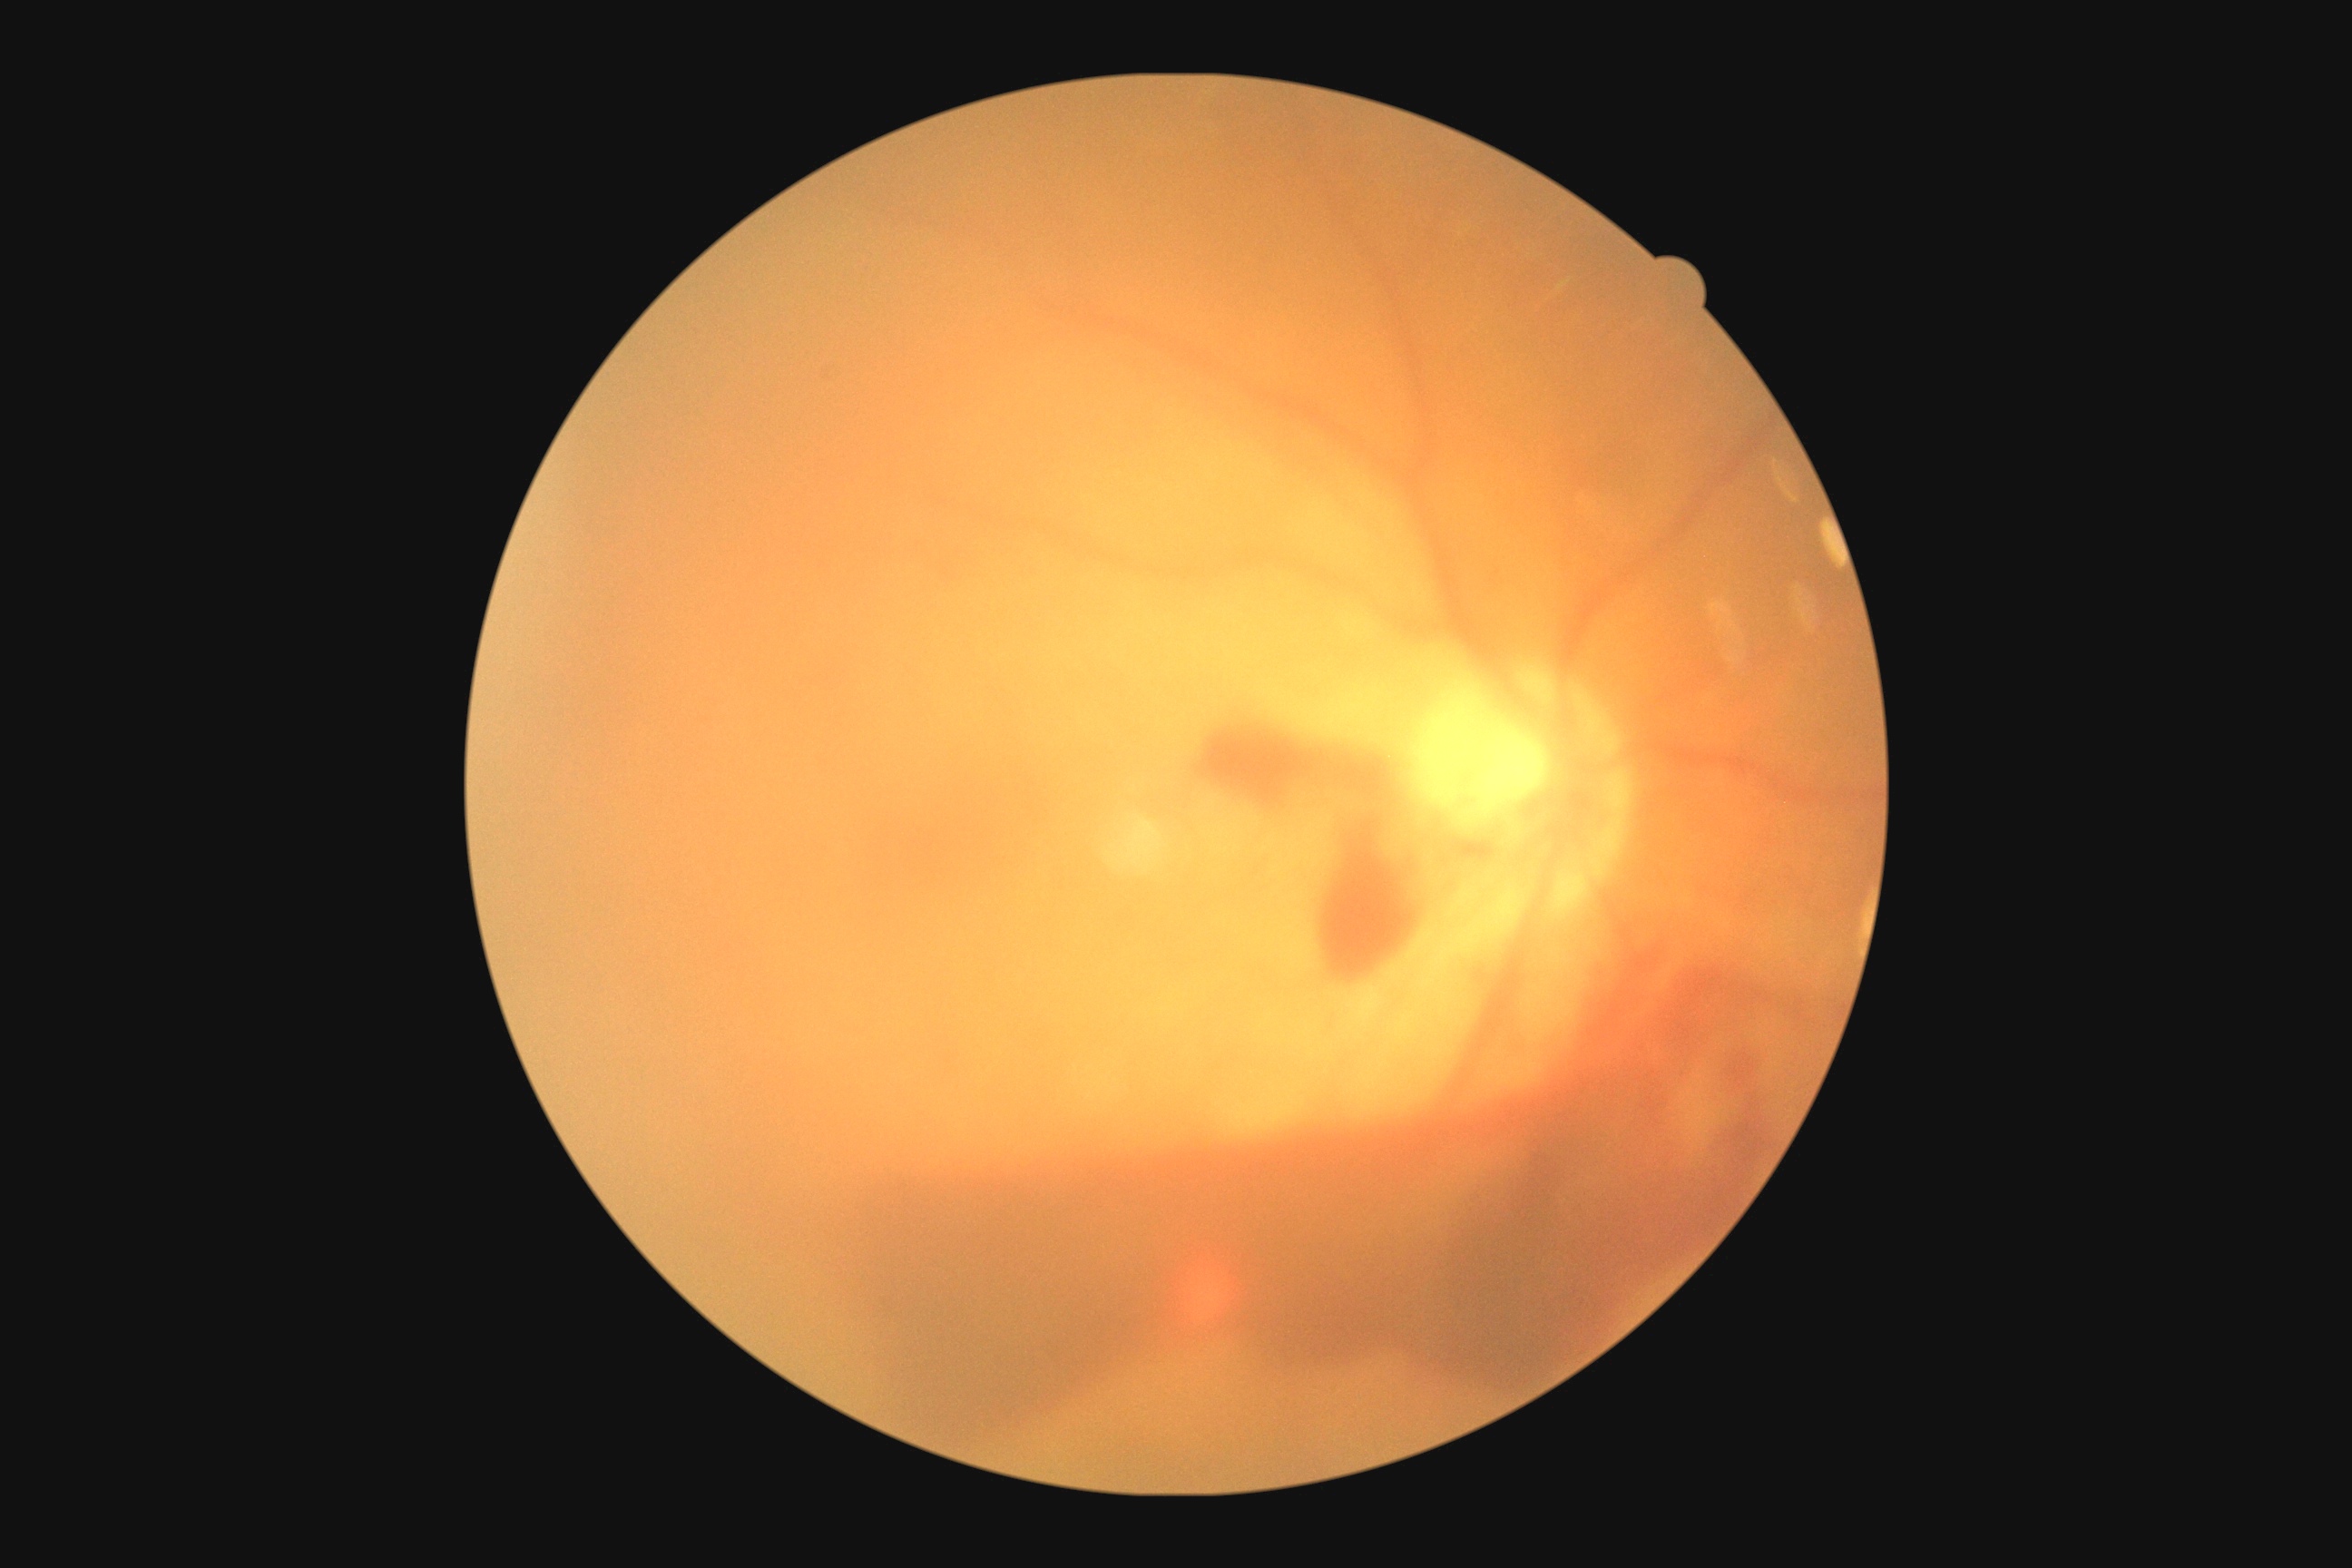
Annotations:
• diabetic retinopathy (DR): proliferative diabetic retinopathy (grade 4) — neovascularization and/or vitreous/pre-retinal hemorrhage